Color fundus photograph; NIDEK AFC-230; modified Davis classification
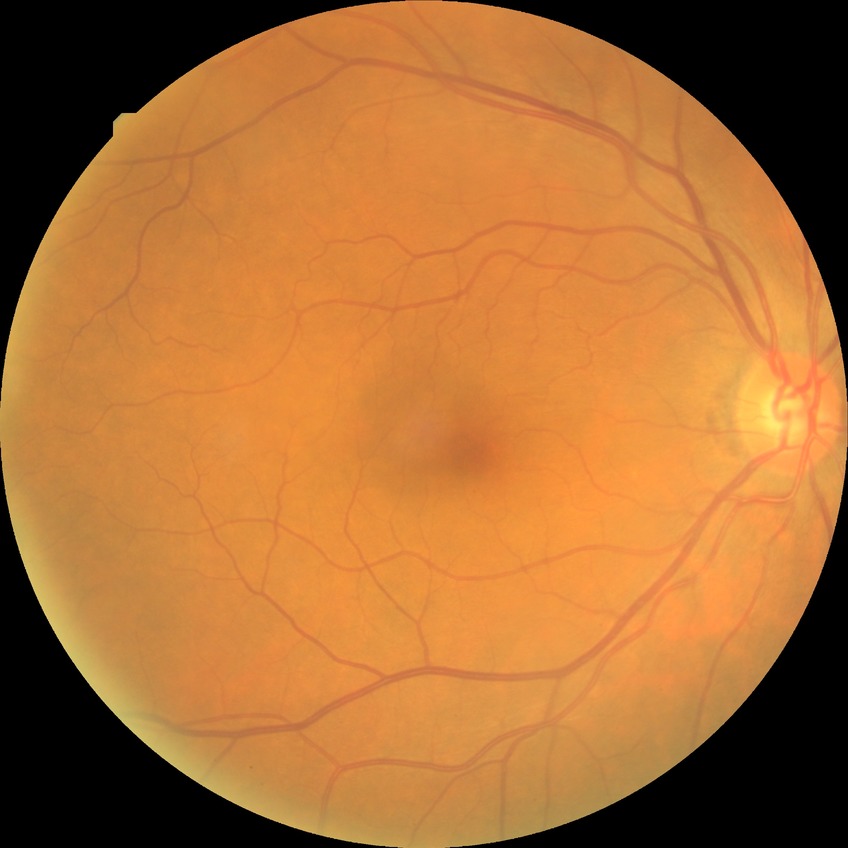
modified Davis classification = no diabetic retinopathy